No pharmacologic dilation · 45° field of view — 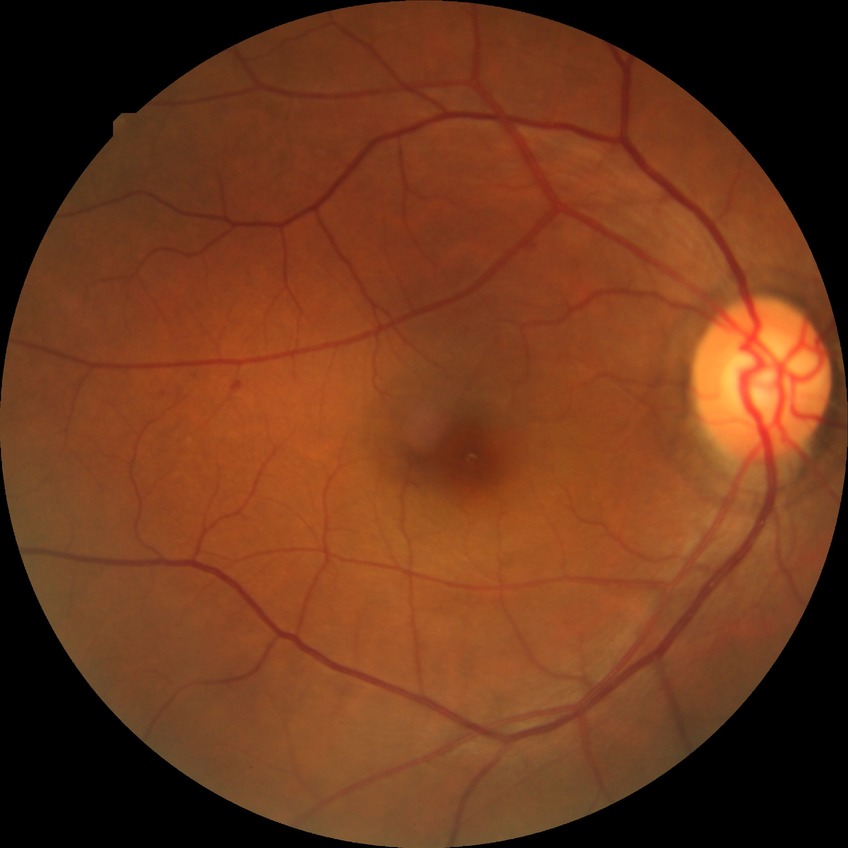
Davis DR grade is SDR.